Clarity RetCam 3, 130° FOV. Pediatric wide-field fundus photograph. 640x480px: 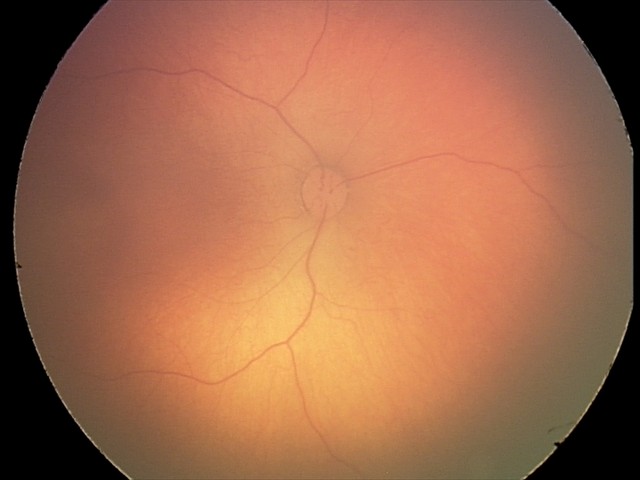
Screening examination with no abnormal retinal findings.